Color fundus photograph, NIDEK AFC-230 fundus camera, nonmydriatic, 45° field of view — 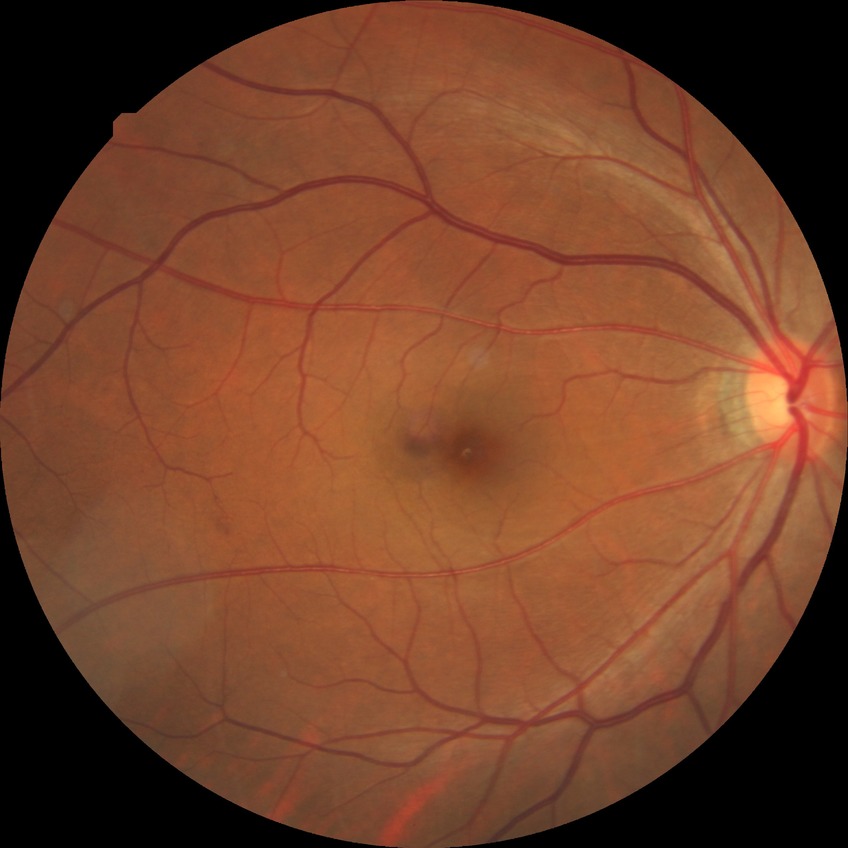 Modified Davis grading: no diabetic retinopathy.